FOV: 45 degrees: 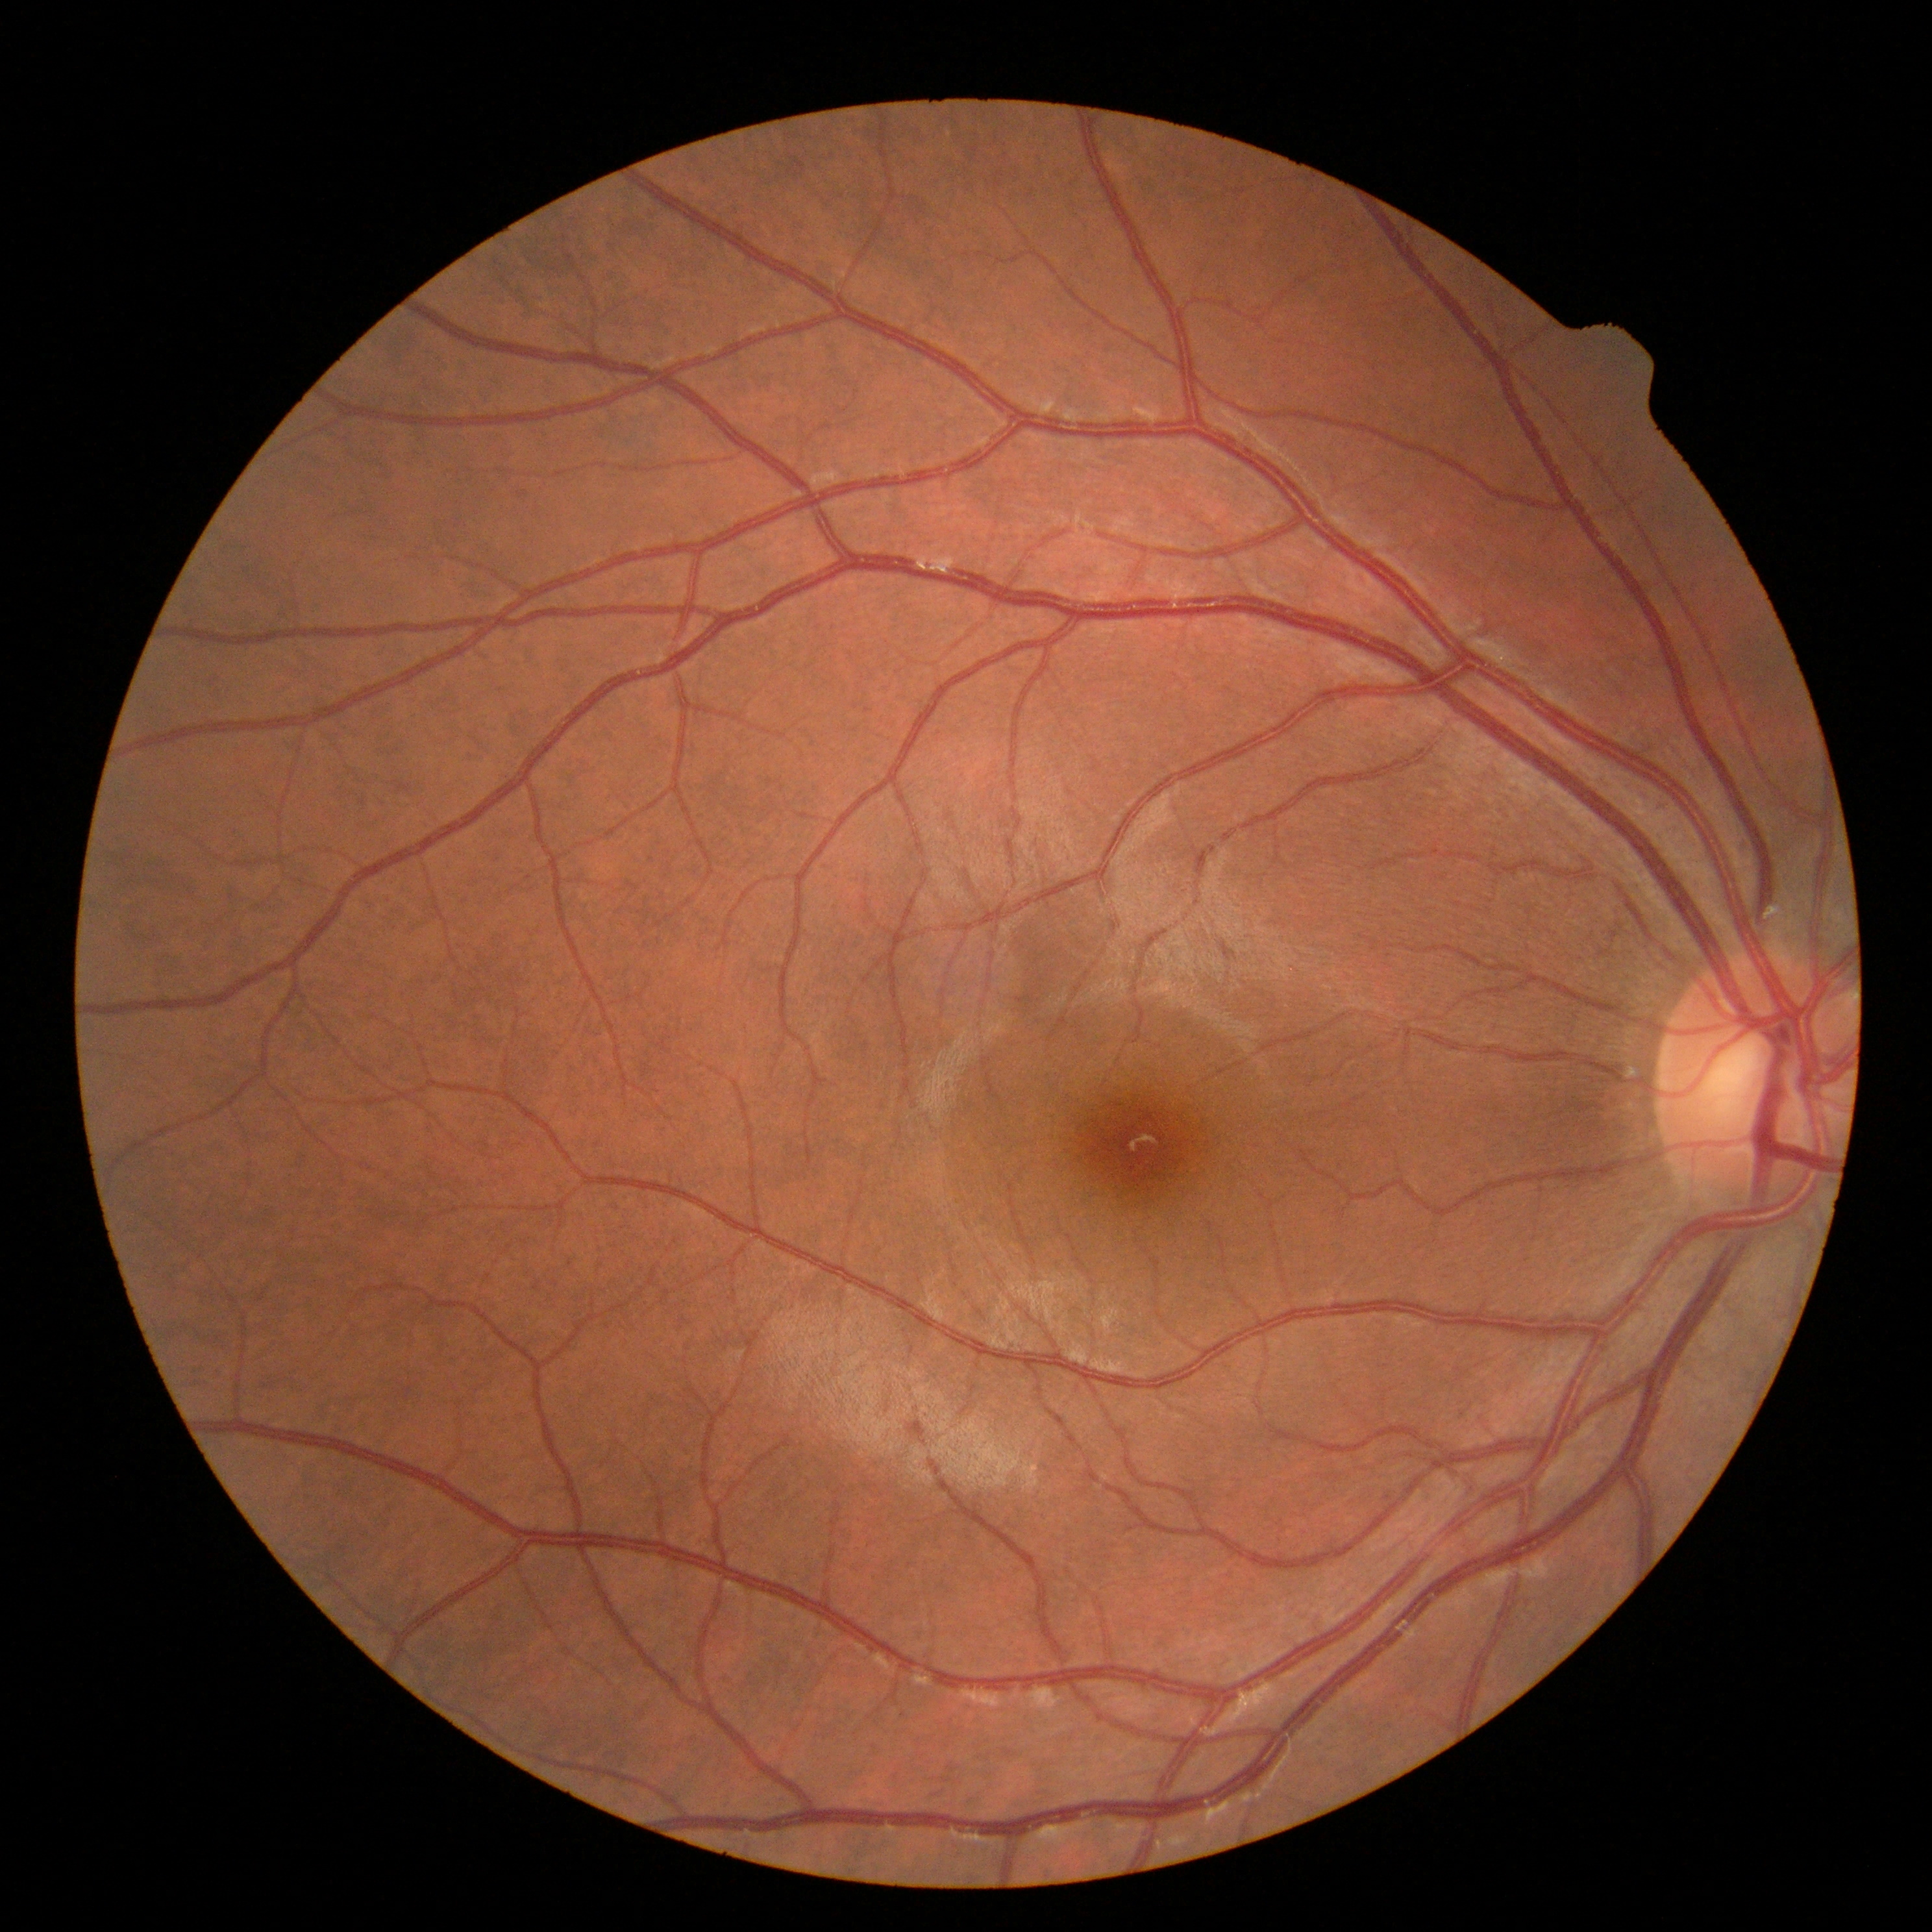

Retinopathy grade is 0 (no apparent retinopathy) — no visible signs of diabetic retinopathy.